Ultra-widefield fundus photograph — 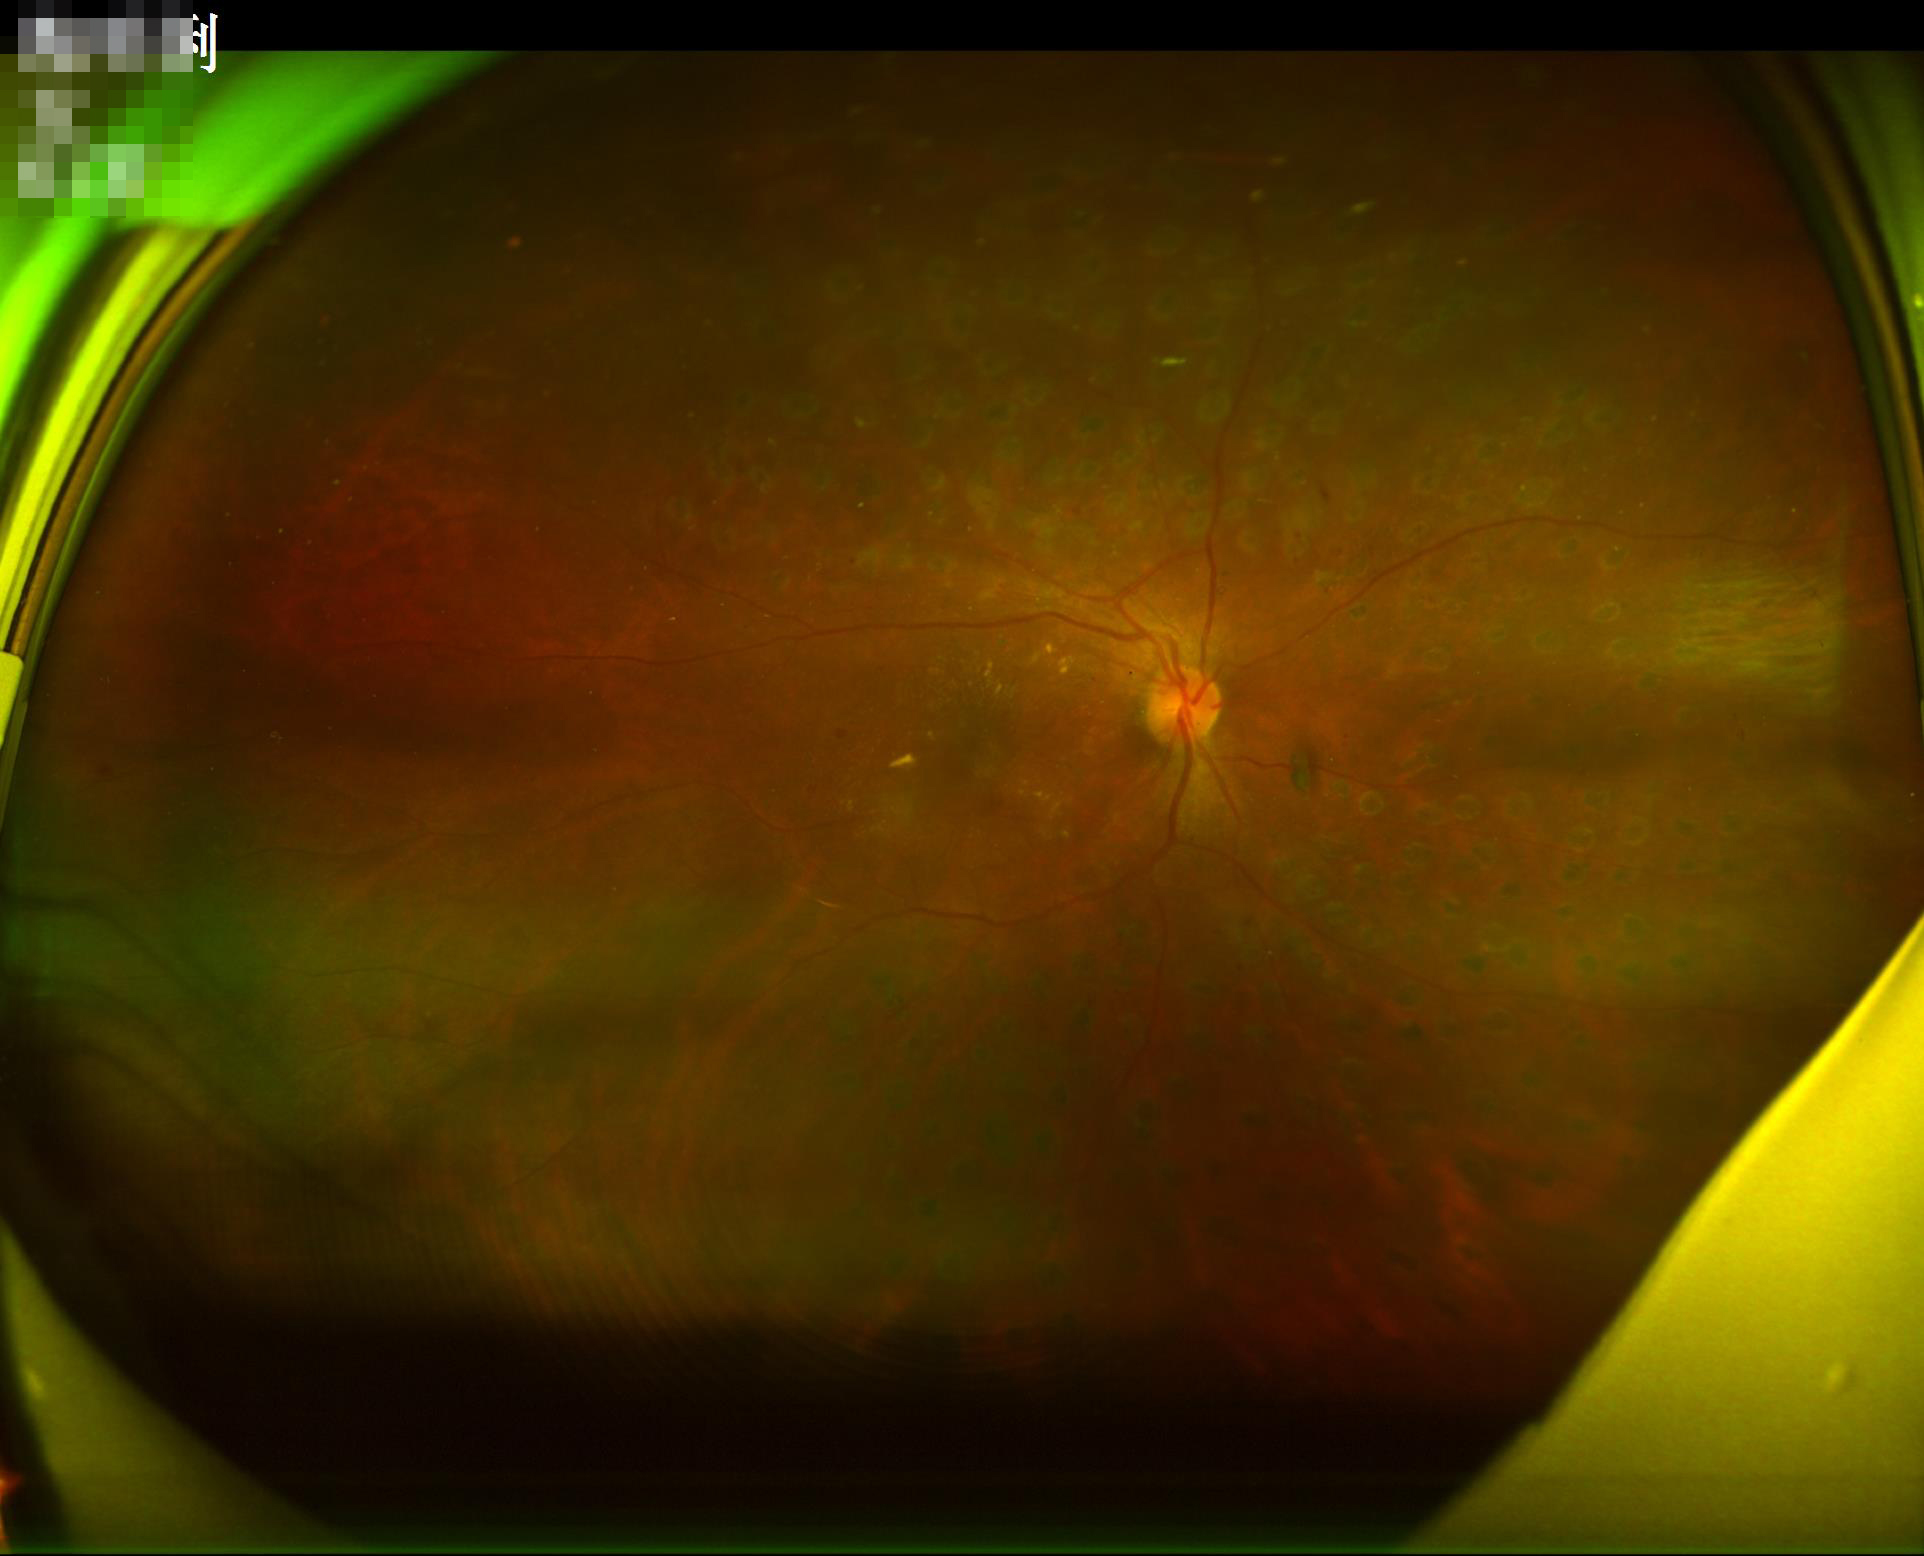 Image quality is suboptimal. Noticeable blur in the optic disc, vessels, or background. Illumination and color balance are good.